DR severity per modified Davis staging
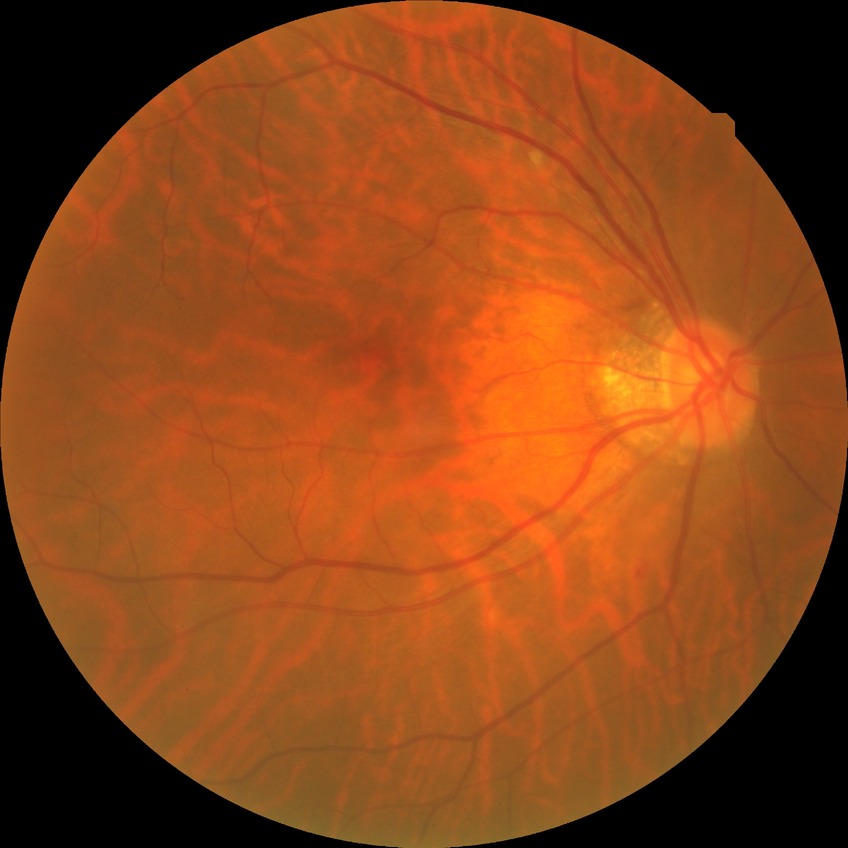
Davis grade is NDR. No signs of diabetic retinopathy.